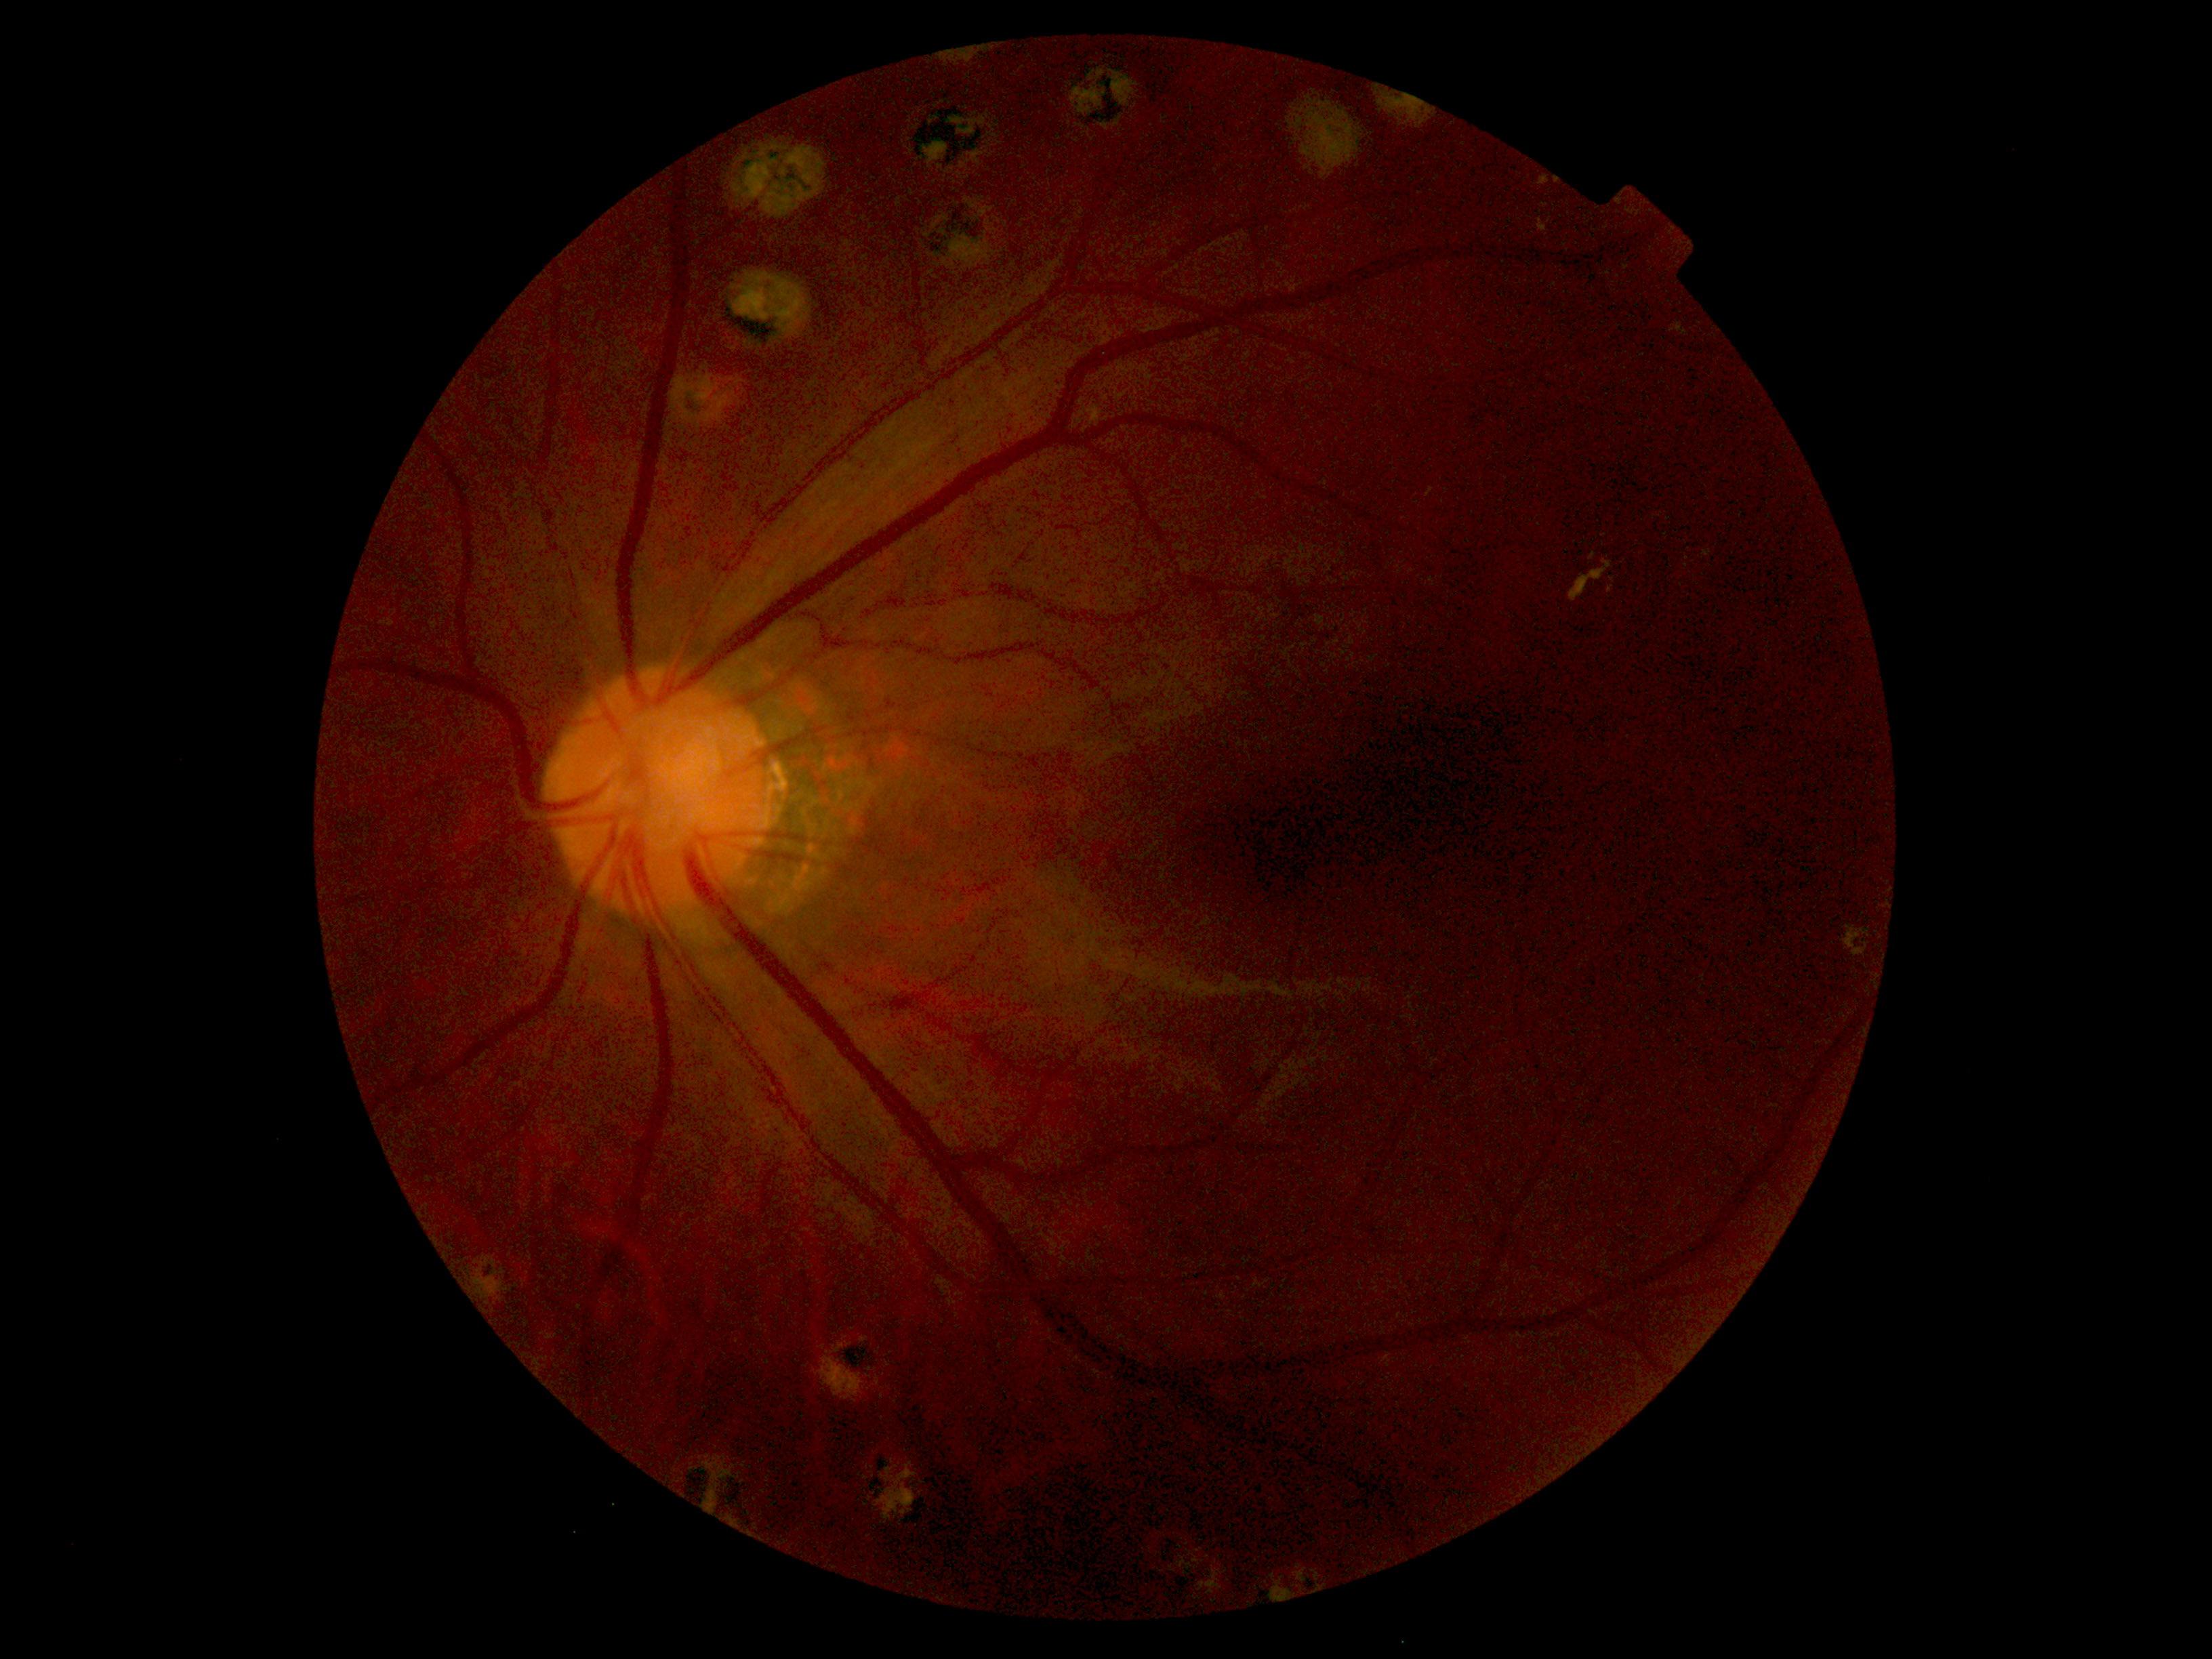

Diabetic retinopathy grade: moderate non-proliferative diabetic retinopathy (2).
The retinopathy is classified as non-proliferative diabetic retinopathy.